CFP. 45° field of view. Image size 2212x1659
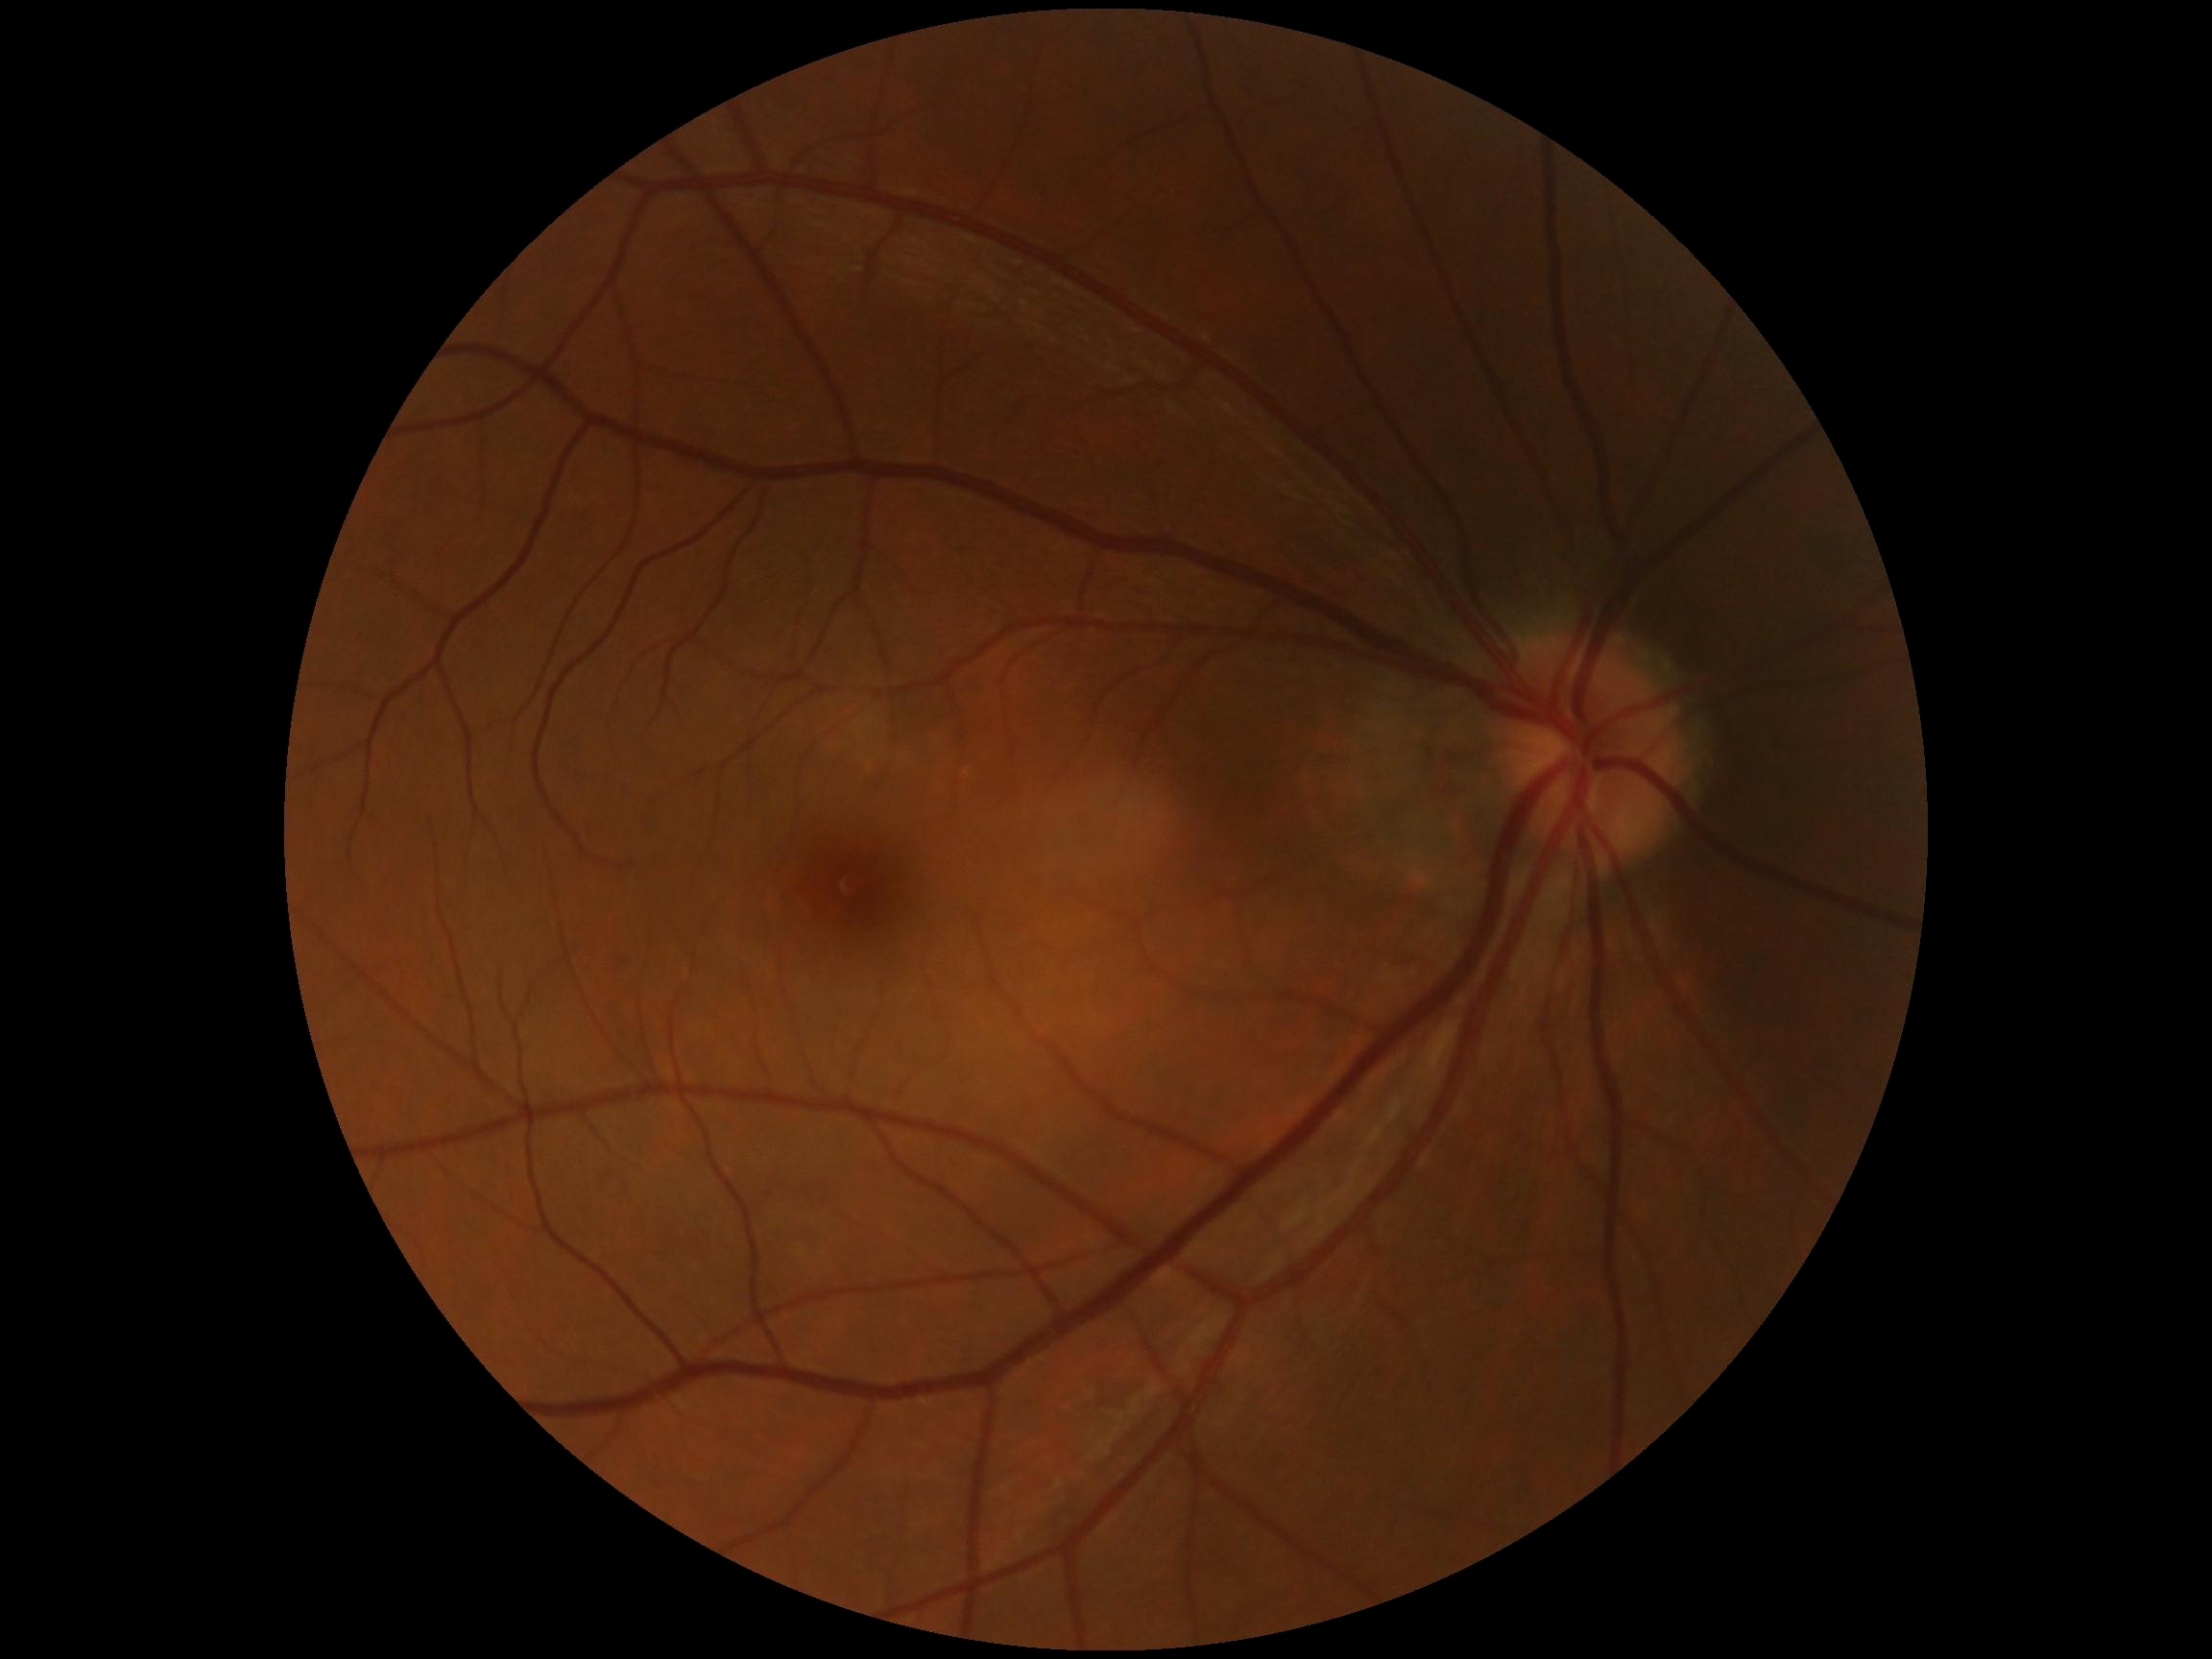

DR impression = no DR findings | DR severity = no apparent diabetic retinopathy (grade 0).